Nidek AFC-330, optic disc region crop, 240 by 240 pixels
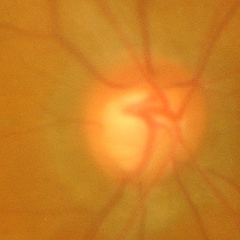

Advanced glaucomatous optic neuropathy.